Infant wide-field retinal image.
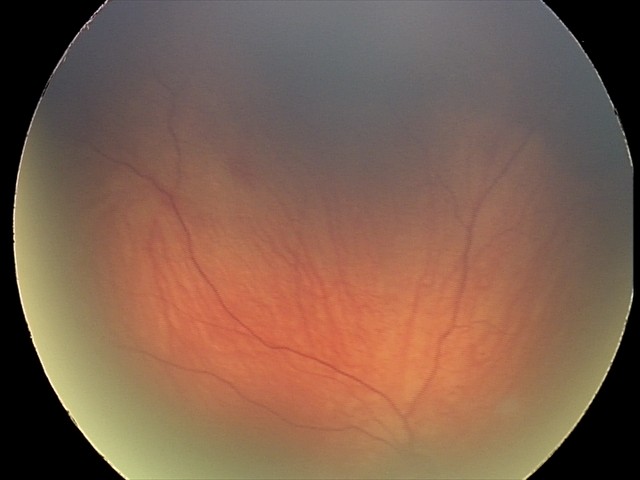 Screening series with retinal hemorrhages.